Color fundus photograph · 45-degree field of view — 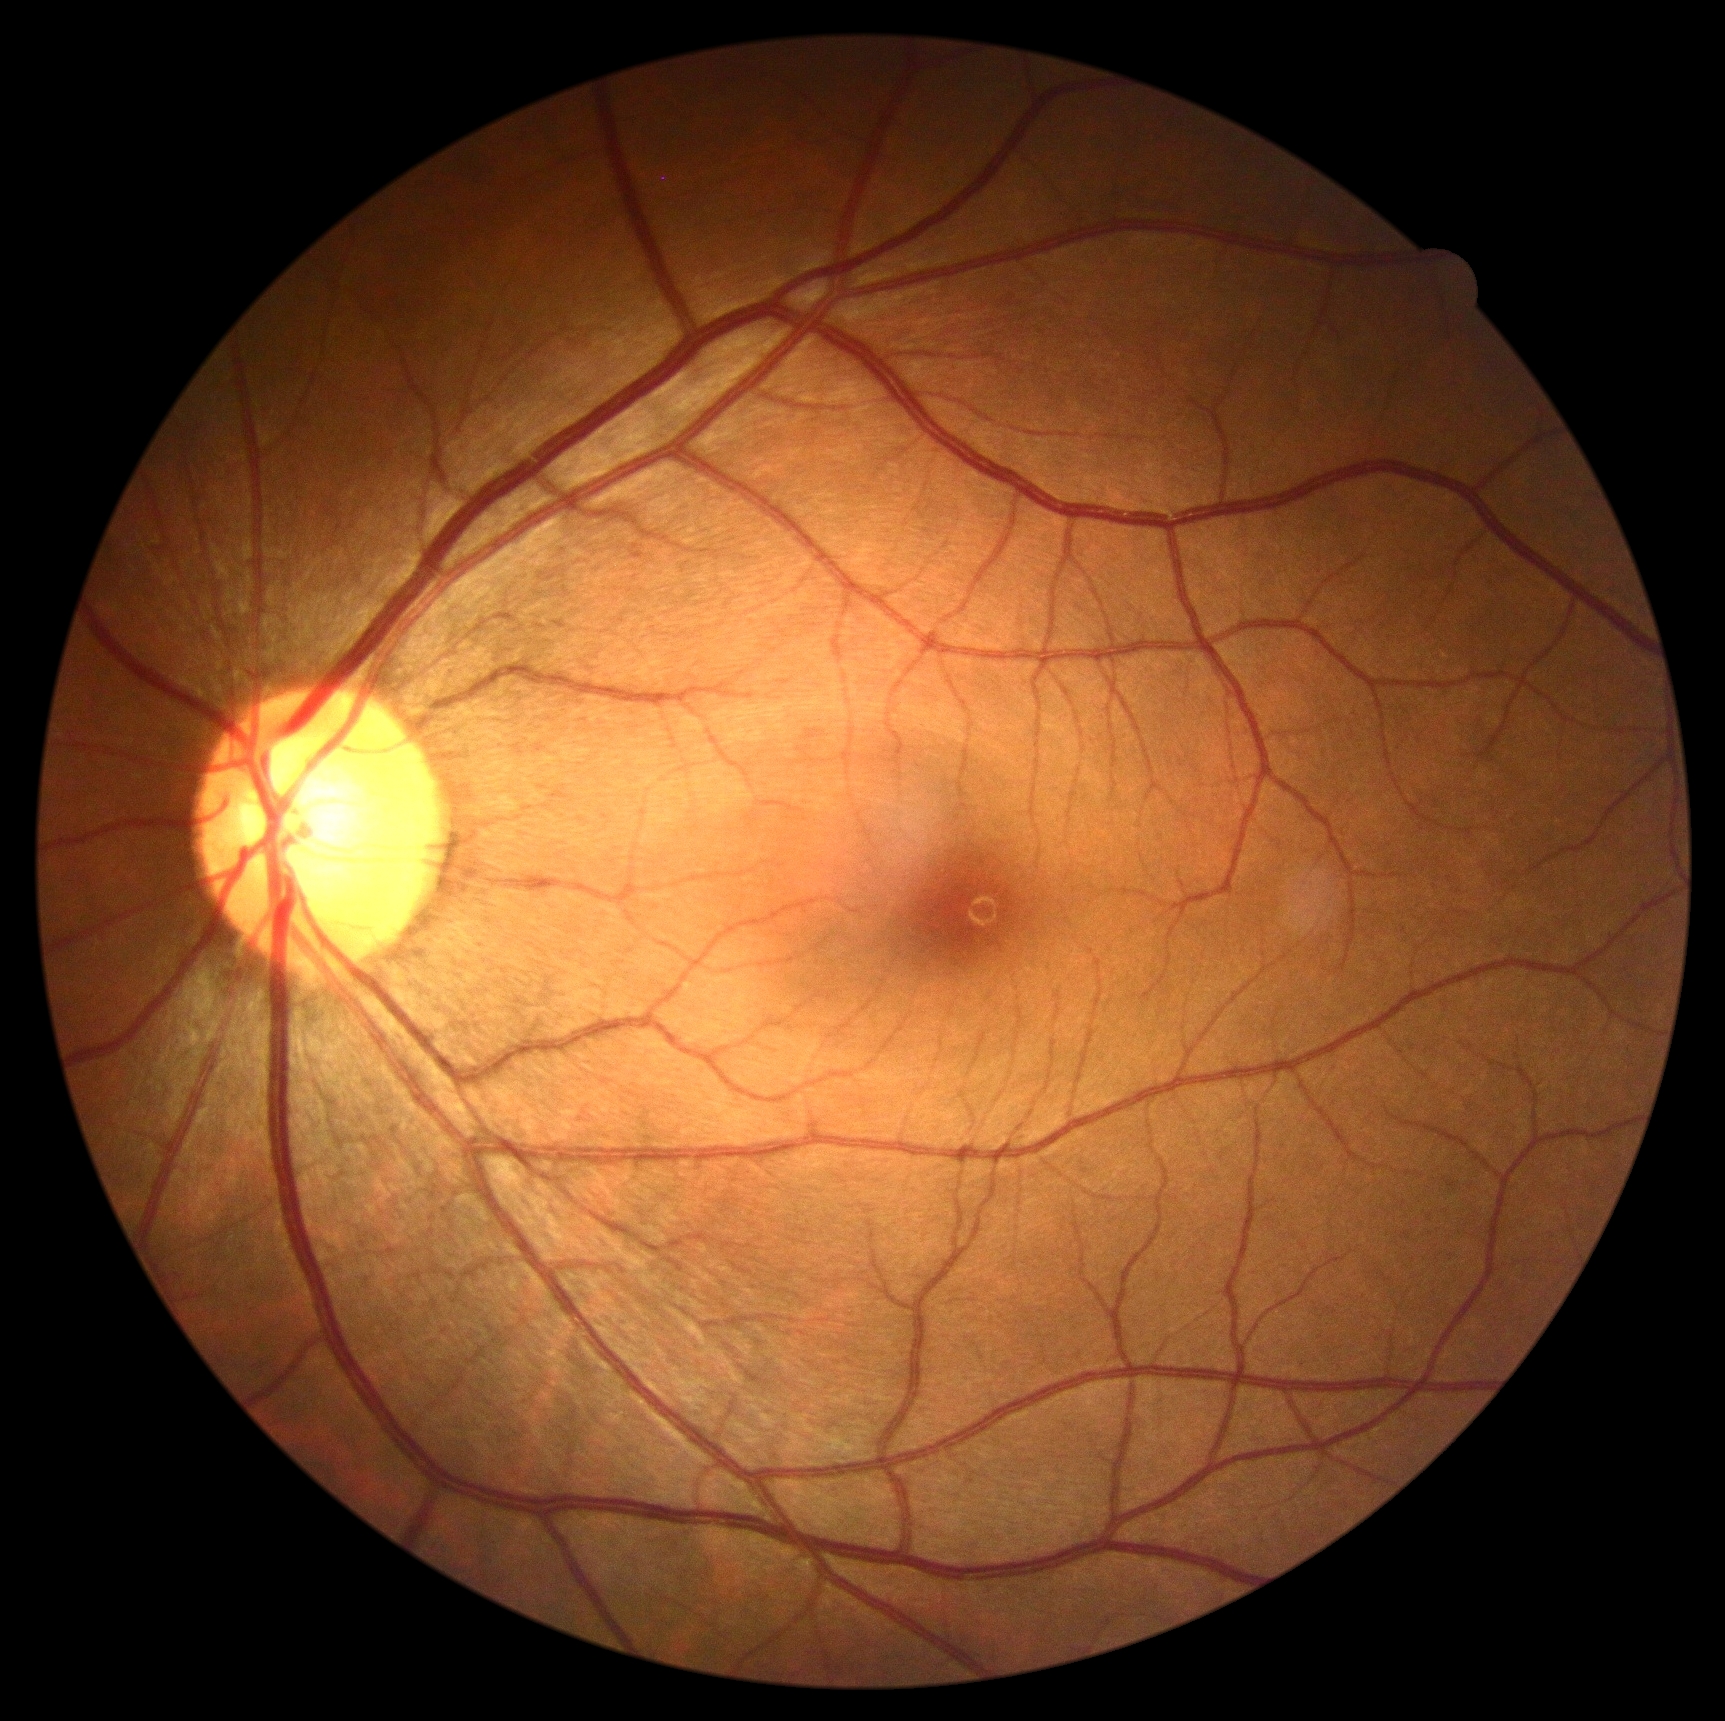

DR stage: no apparent retinopathy (grade 0) — no visible signs of diabetic retinopathy.